Infant wide-field fundus photograph: 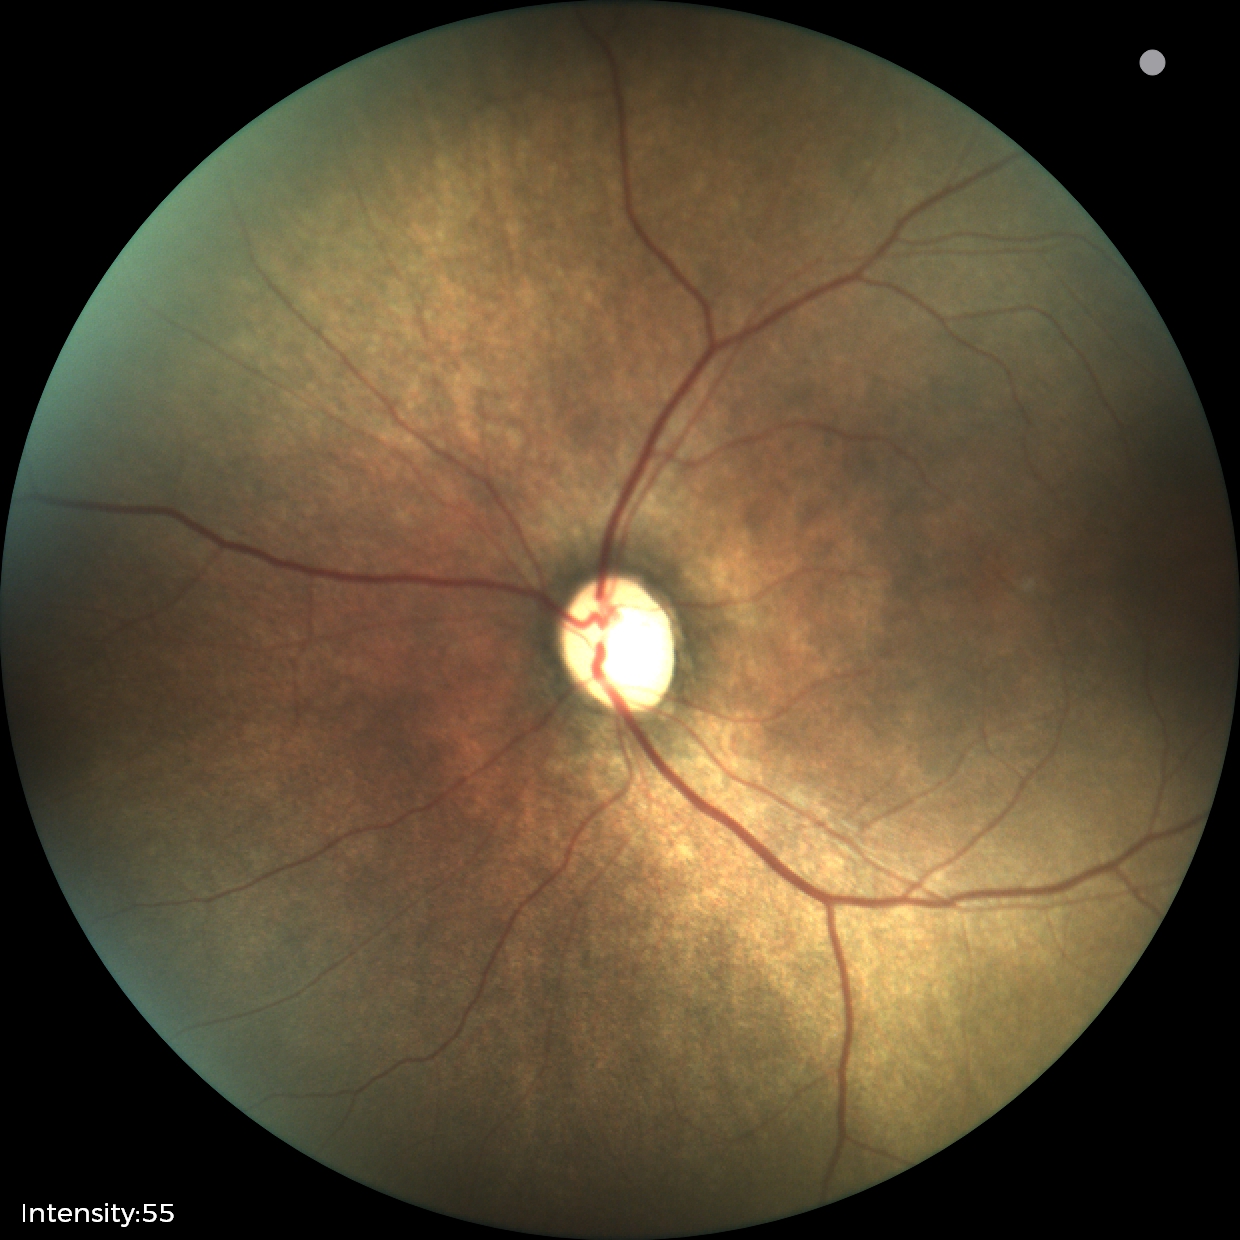 Screening series with status post retinopathy of prematurity.